FOV: 45 degrees · NIDEK AFC-230 · DR severity per modified Davis staging.
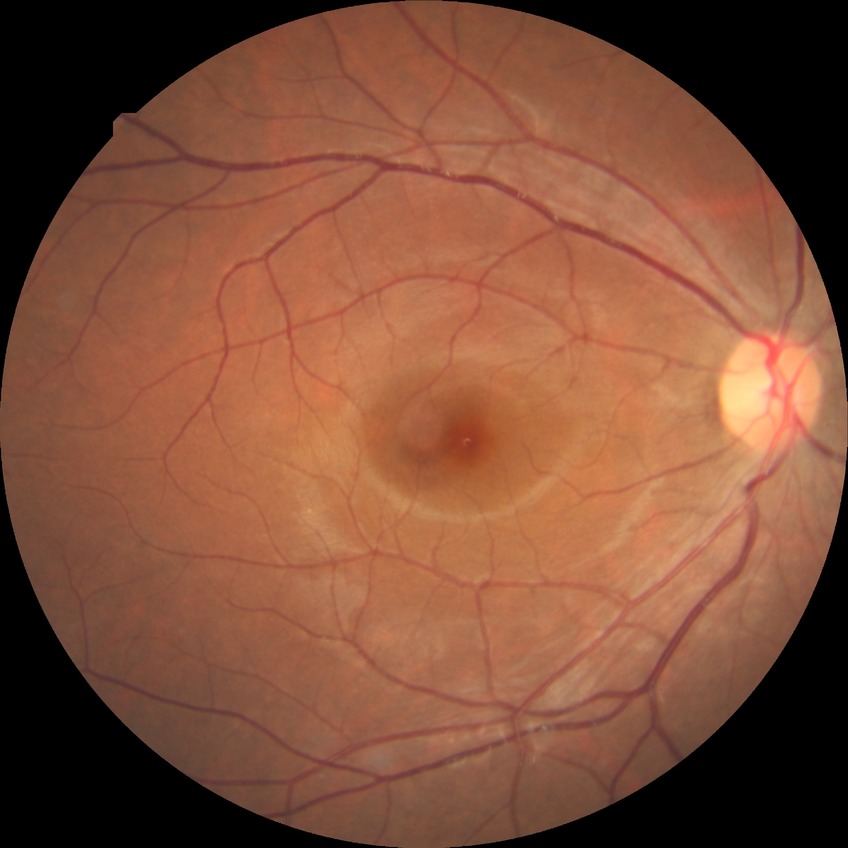
Diabetic retinopathy severity is no diabetic retinopathy.